CFP — 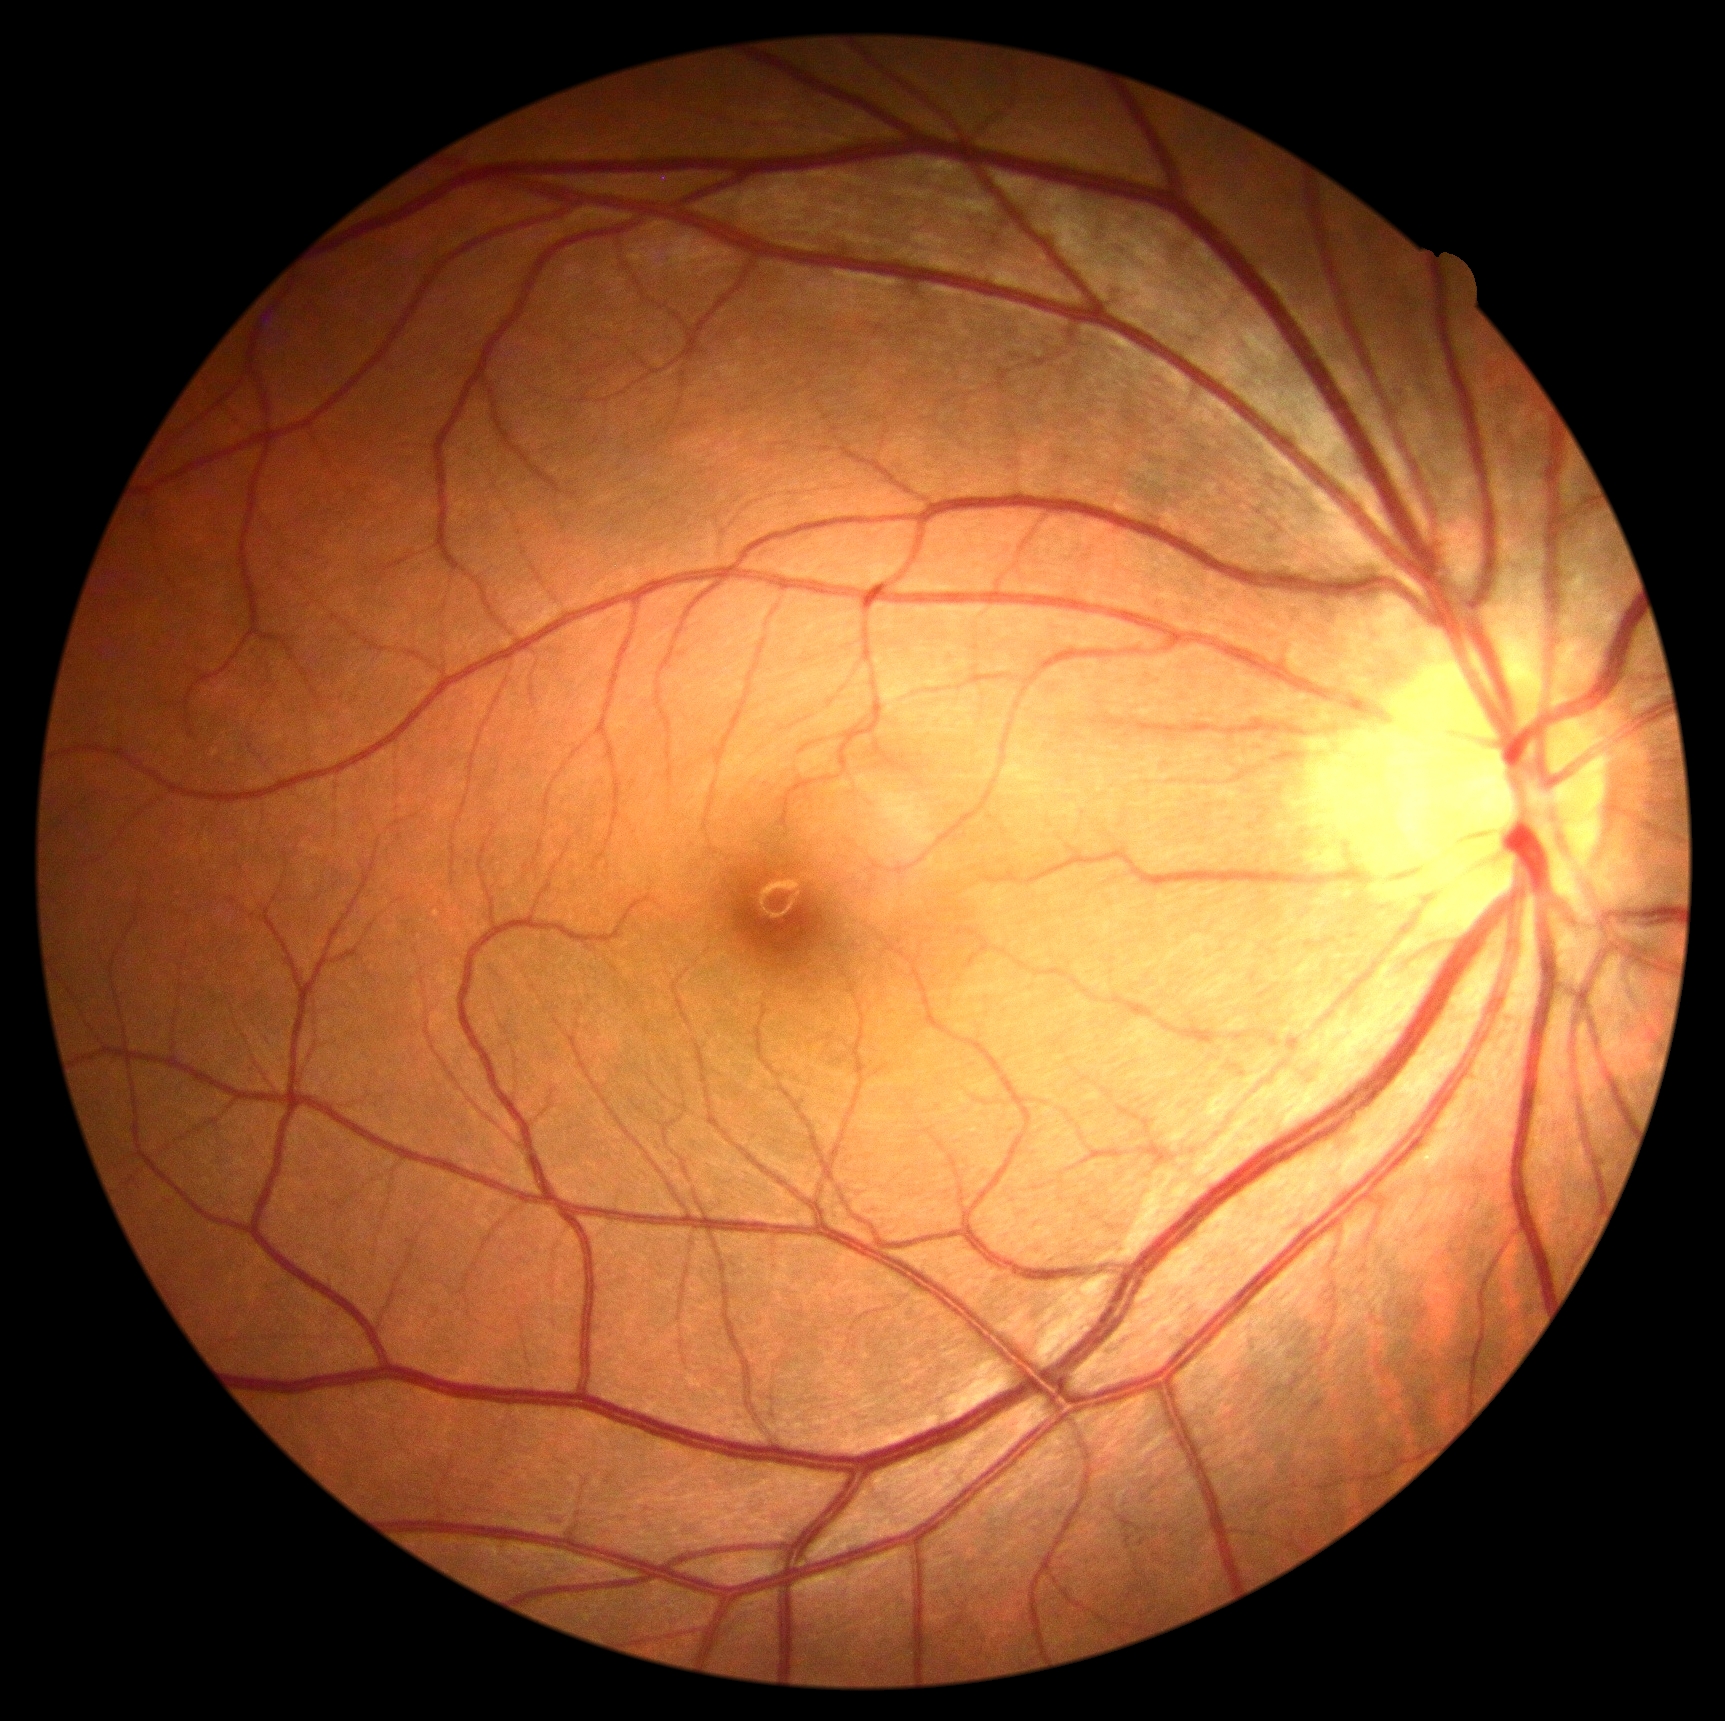

diabetic retinopathy = grade 0 (no apparent retinopathy).